Image size 1920x1088:
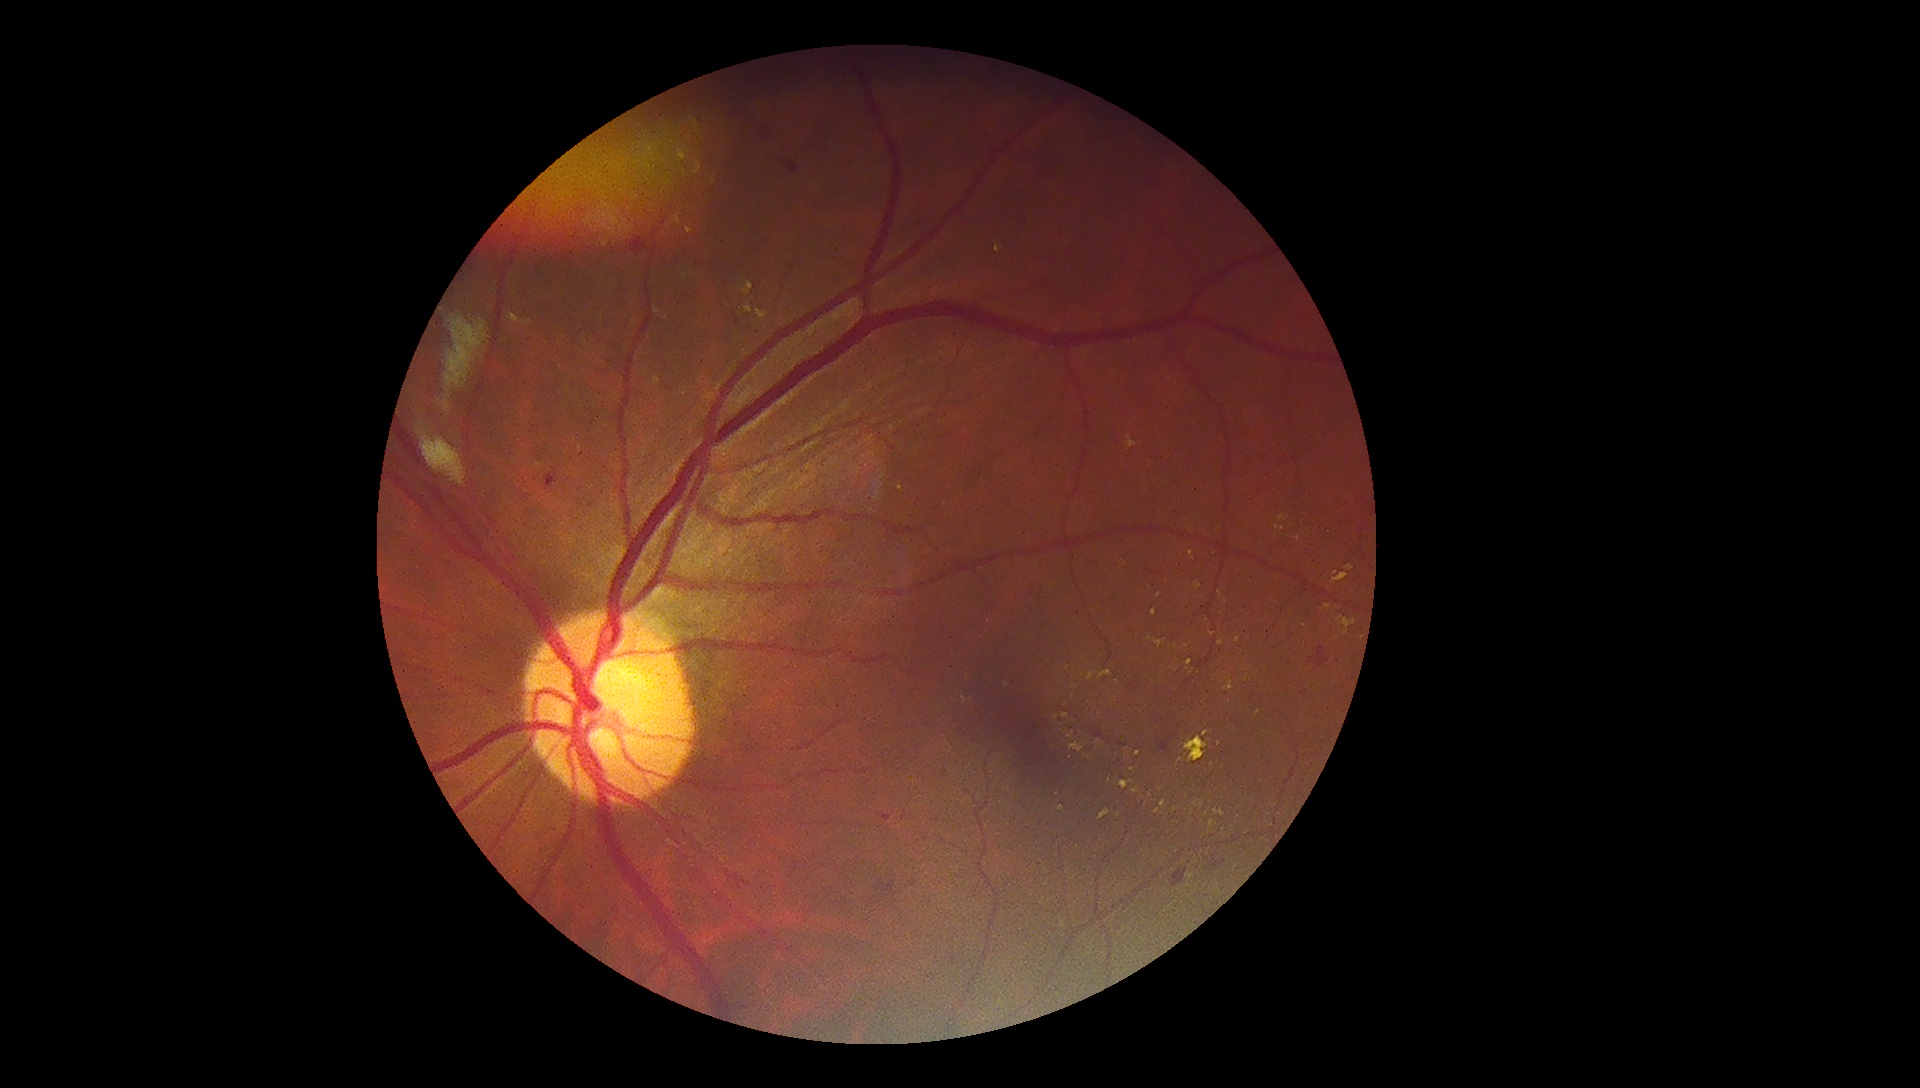

DR class = non-proliferative diabetic retinopathy, retinopathy = 2.